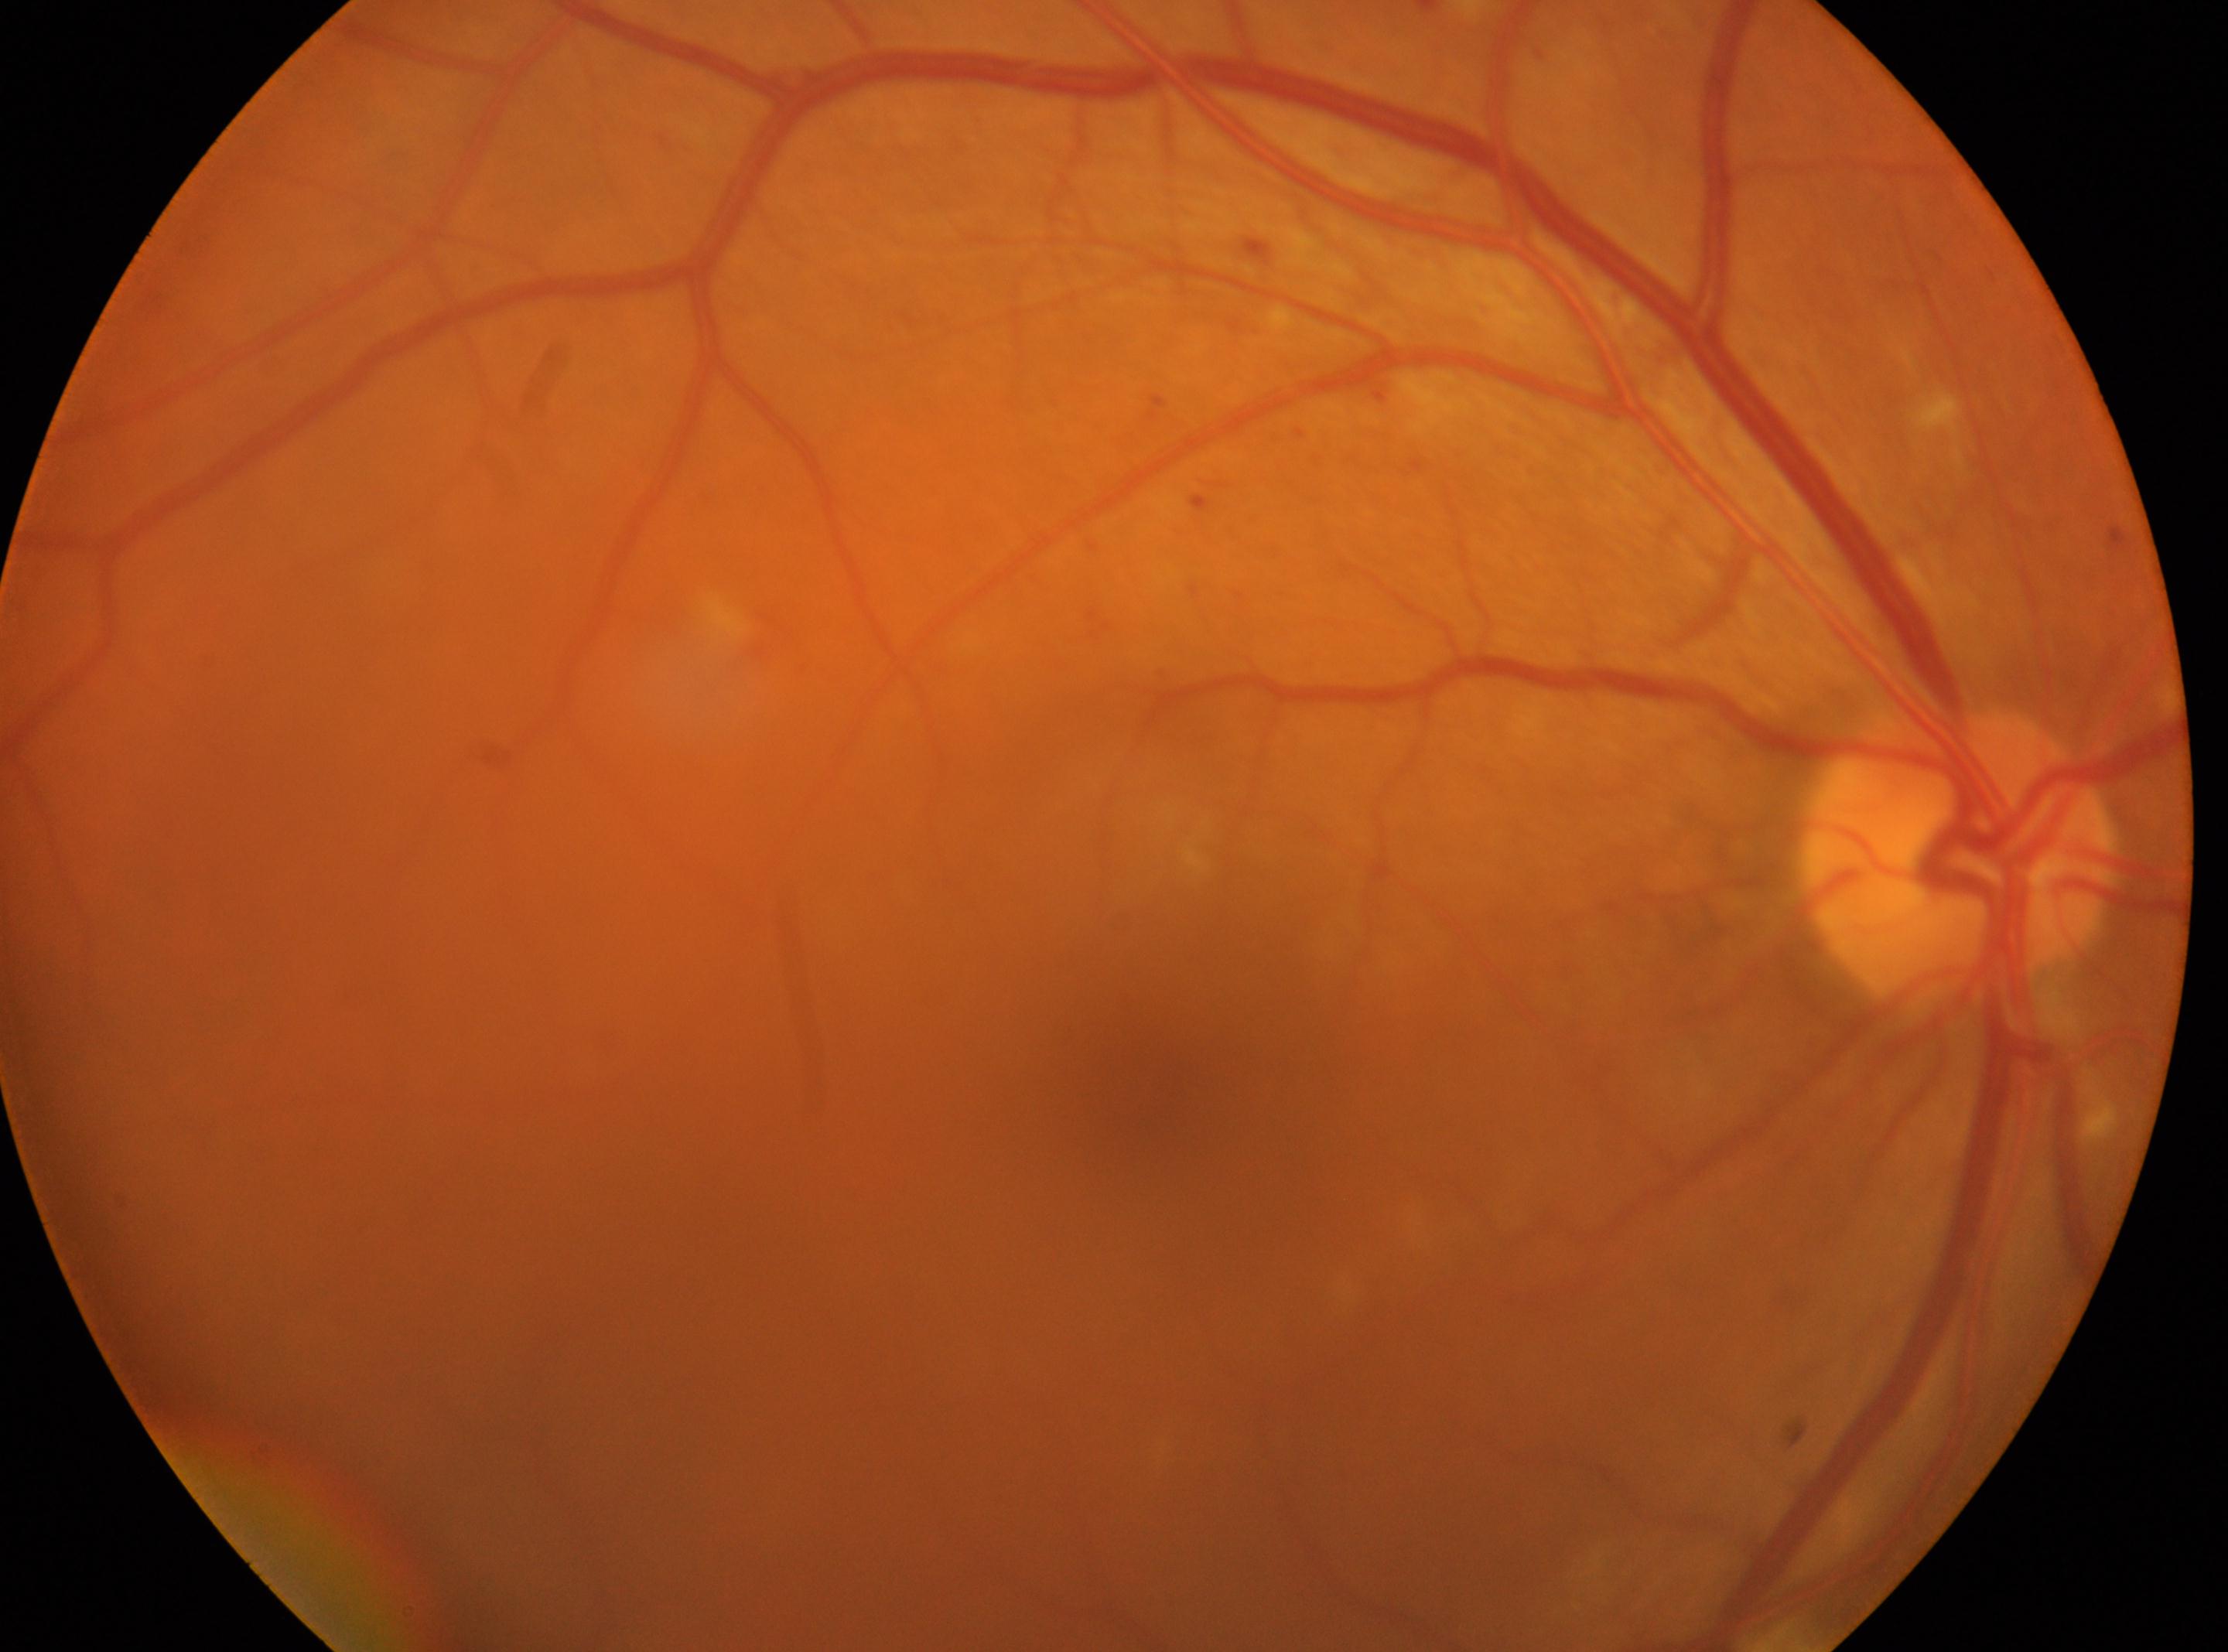

• laterality · the right eye
• macular center · (1145,1083)
• the optic disc · (1954,854)
• diabetic retinopathy (DR) · moderate NPDR (grade 2)